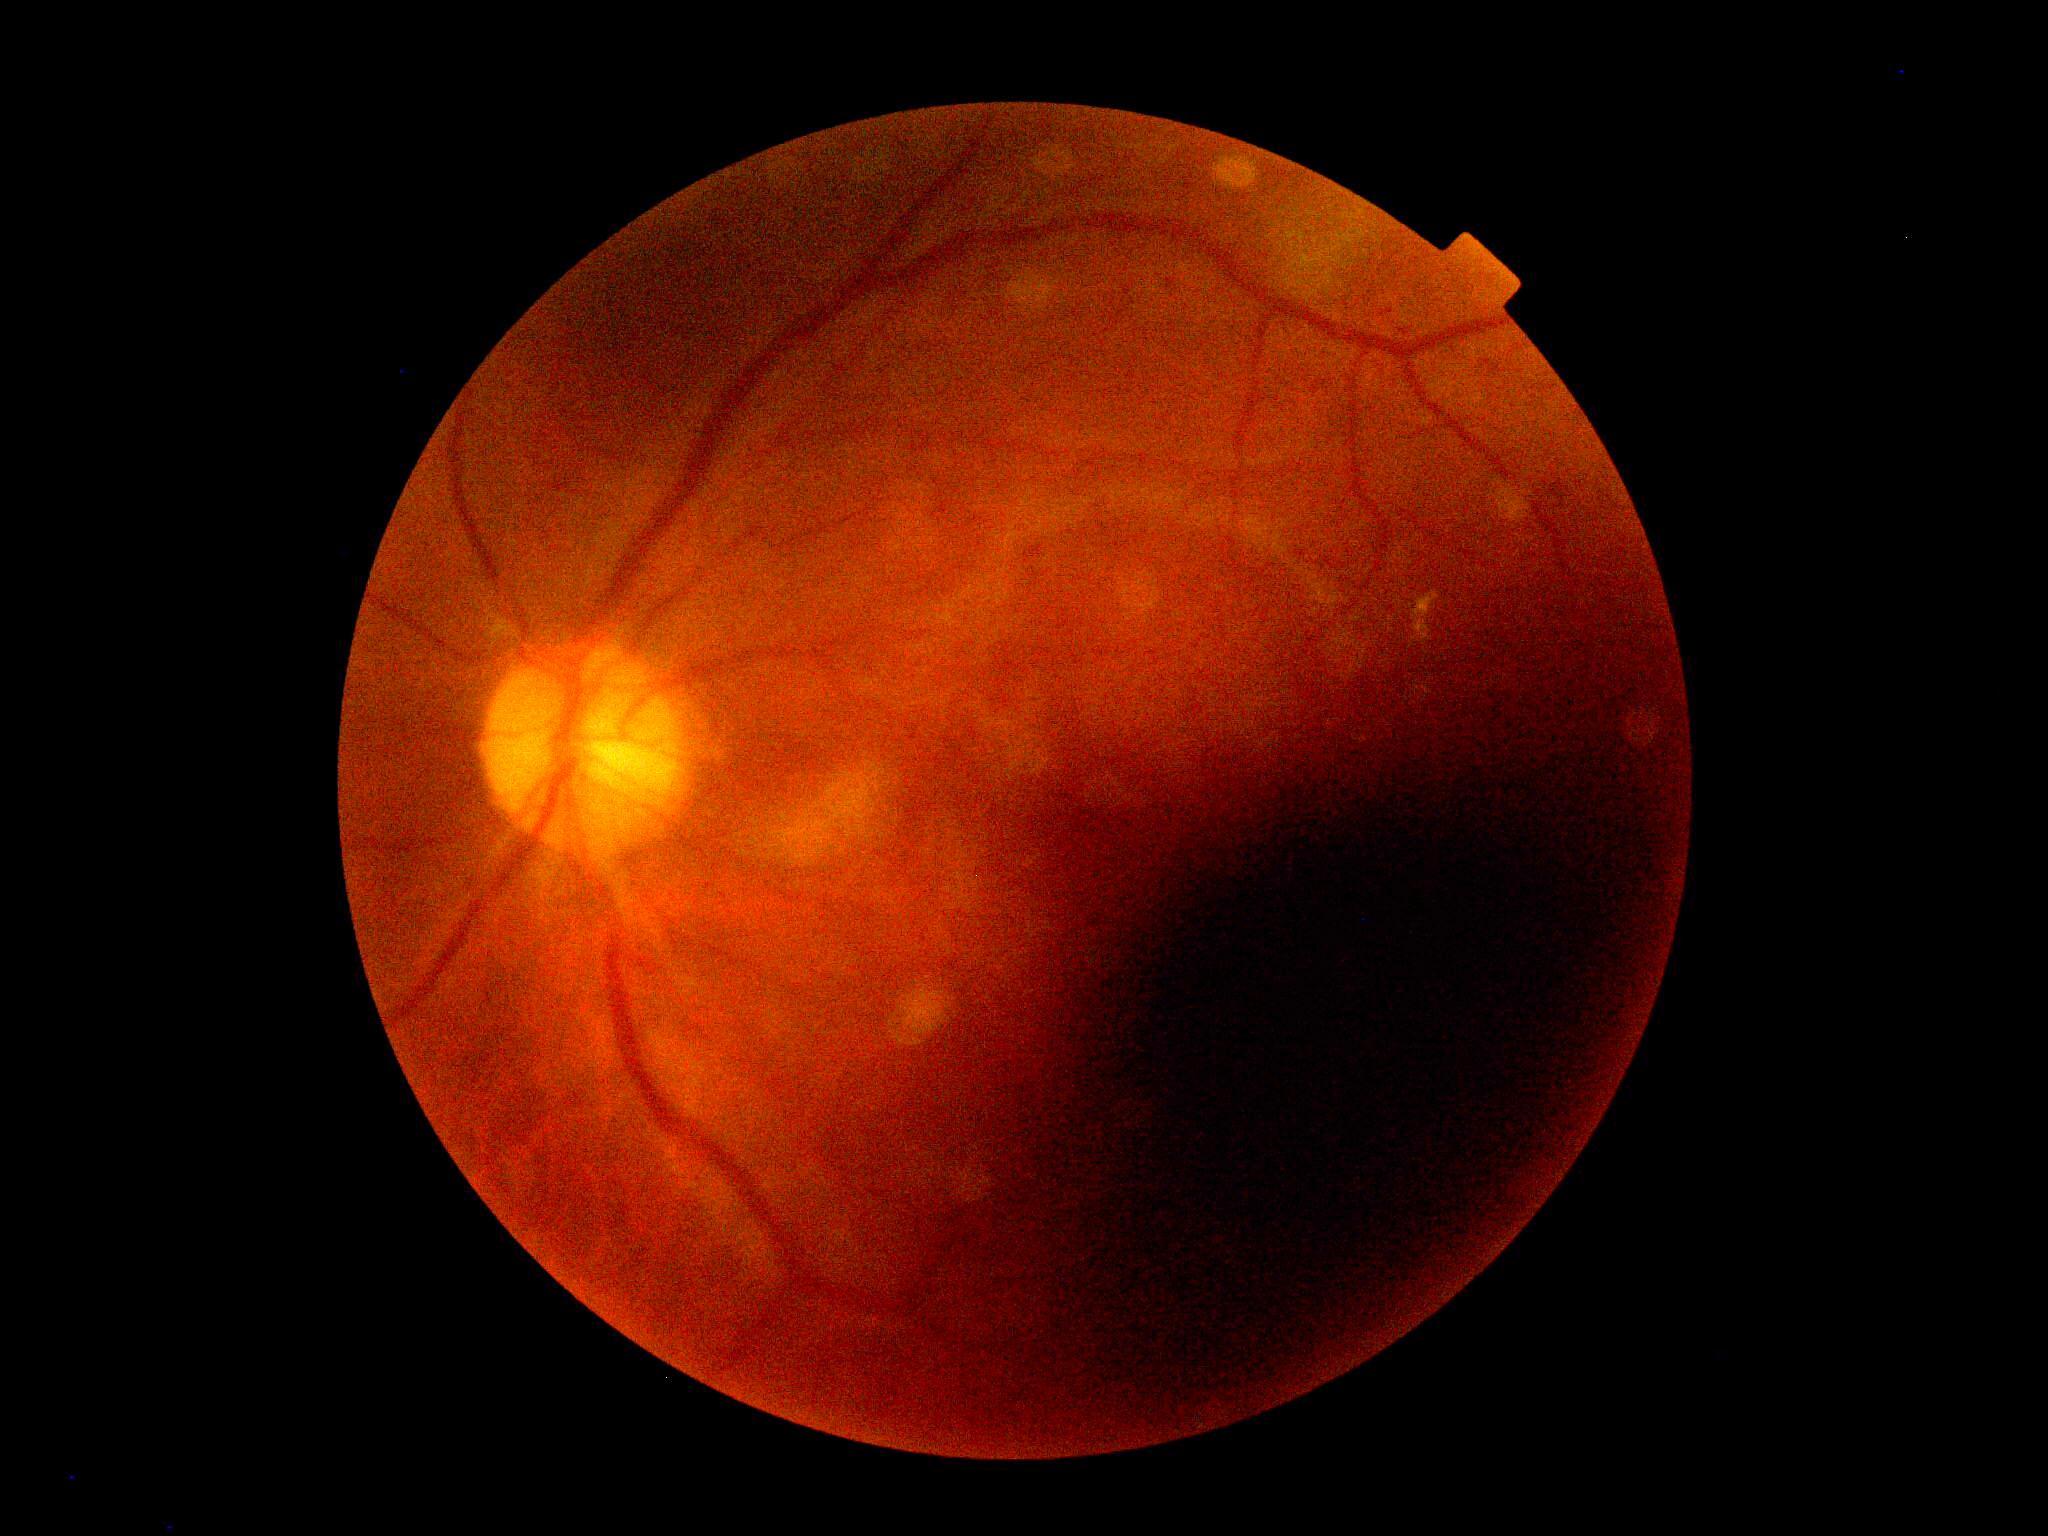

Retinopathy grade is 2/4. The retinopathy is classified as non-proliferative diabetic retinopathy.